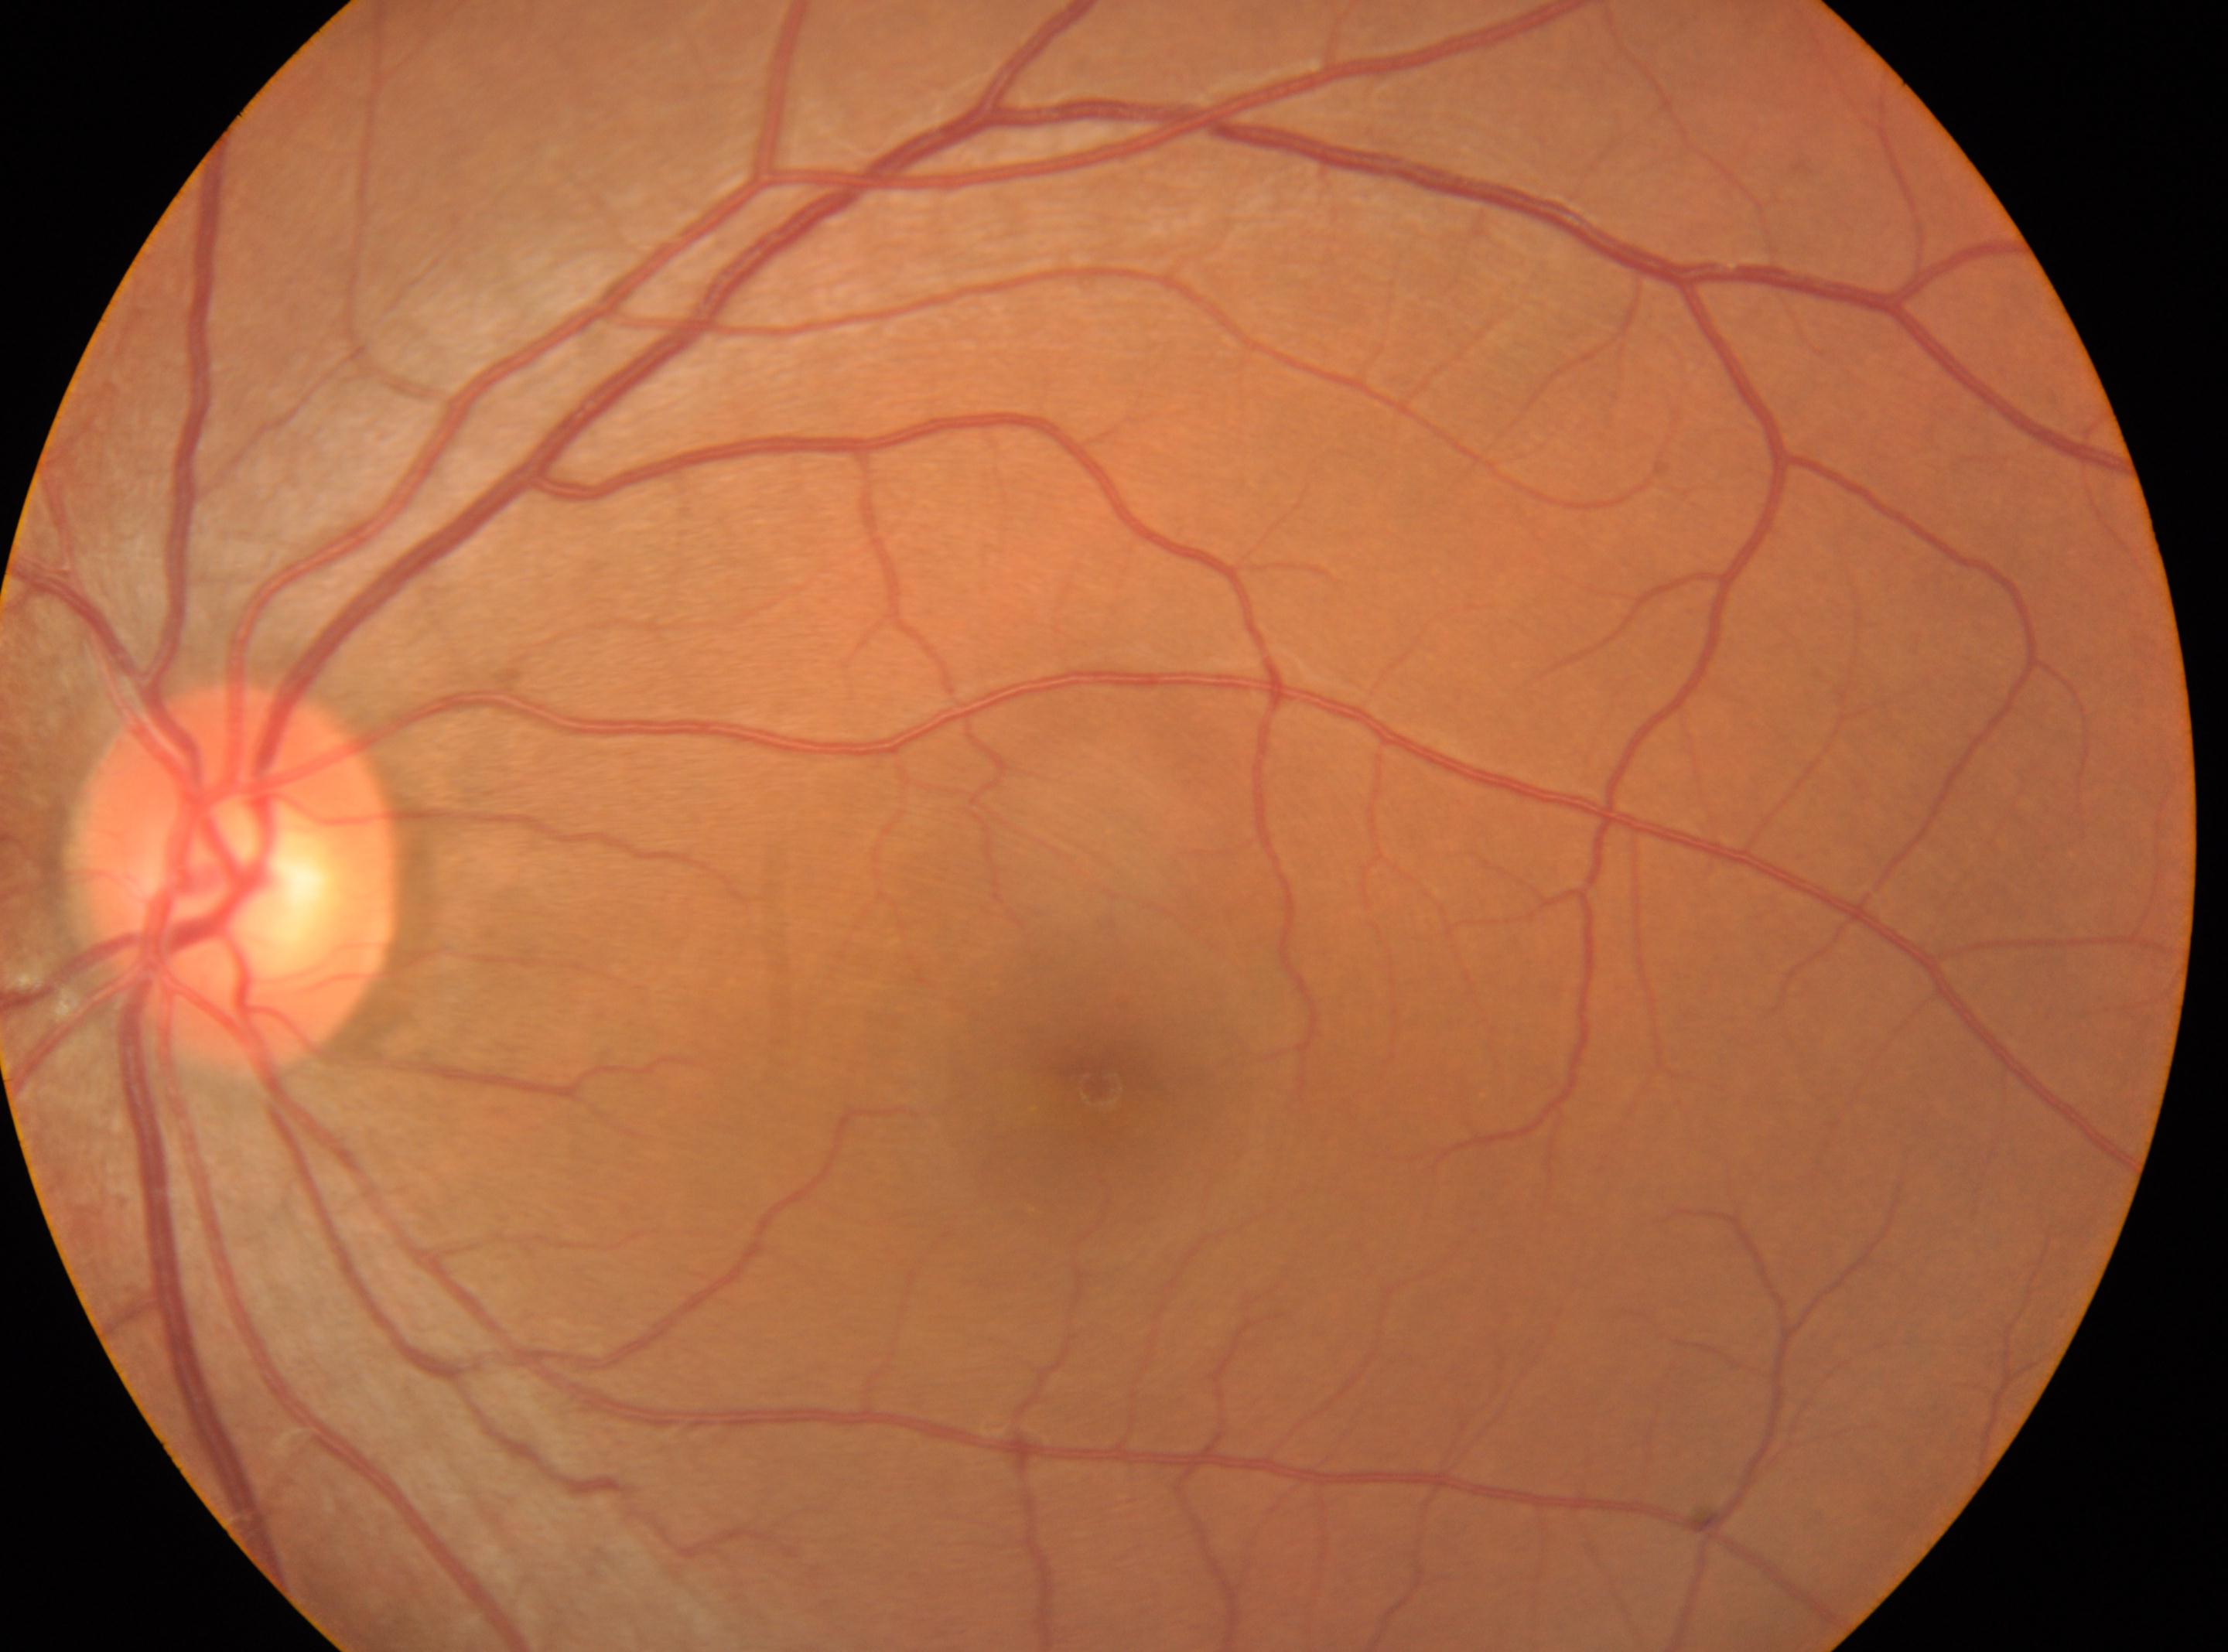
optic disc = x=235, y=875 | laterality = left | fovea = x=1099, y=1087 | DR severity = grade 0.